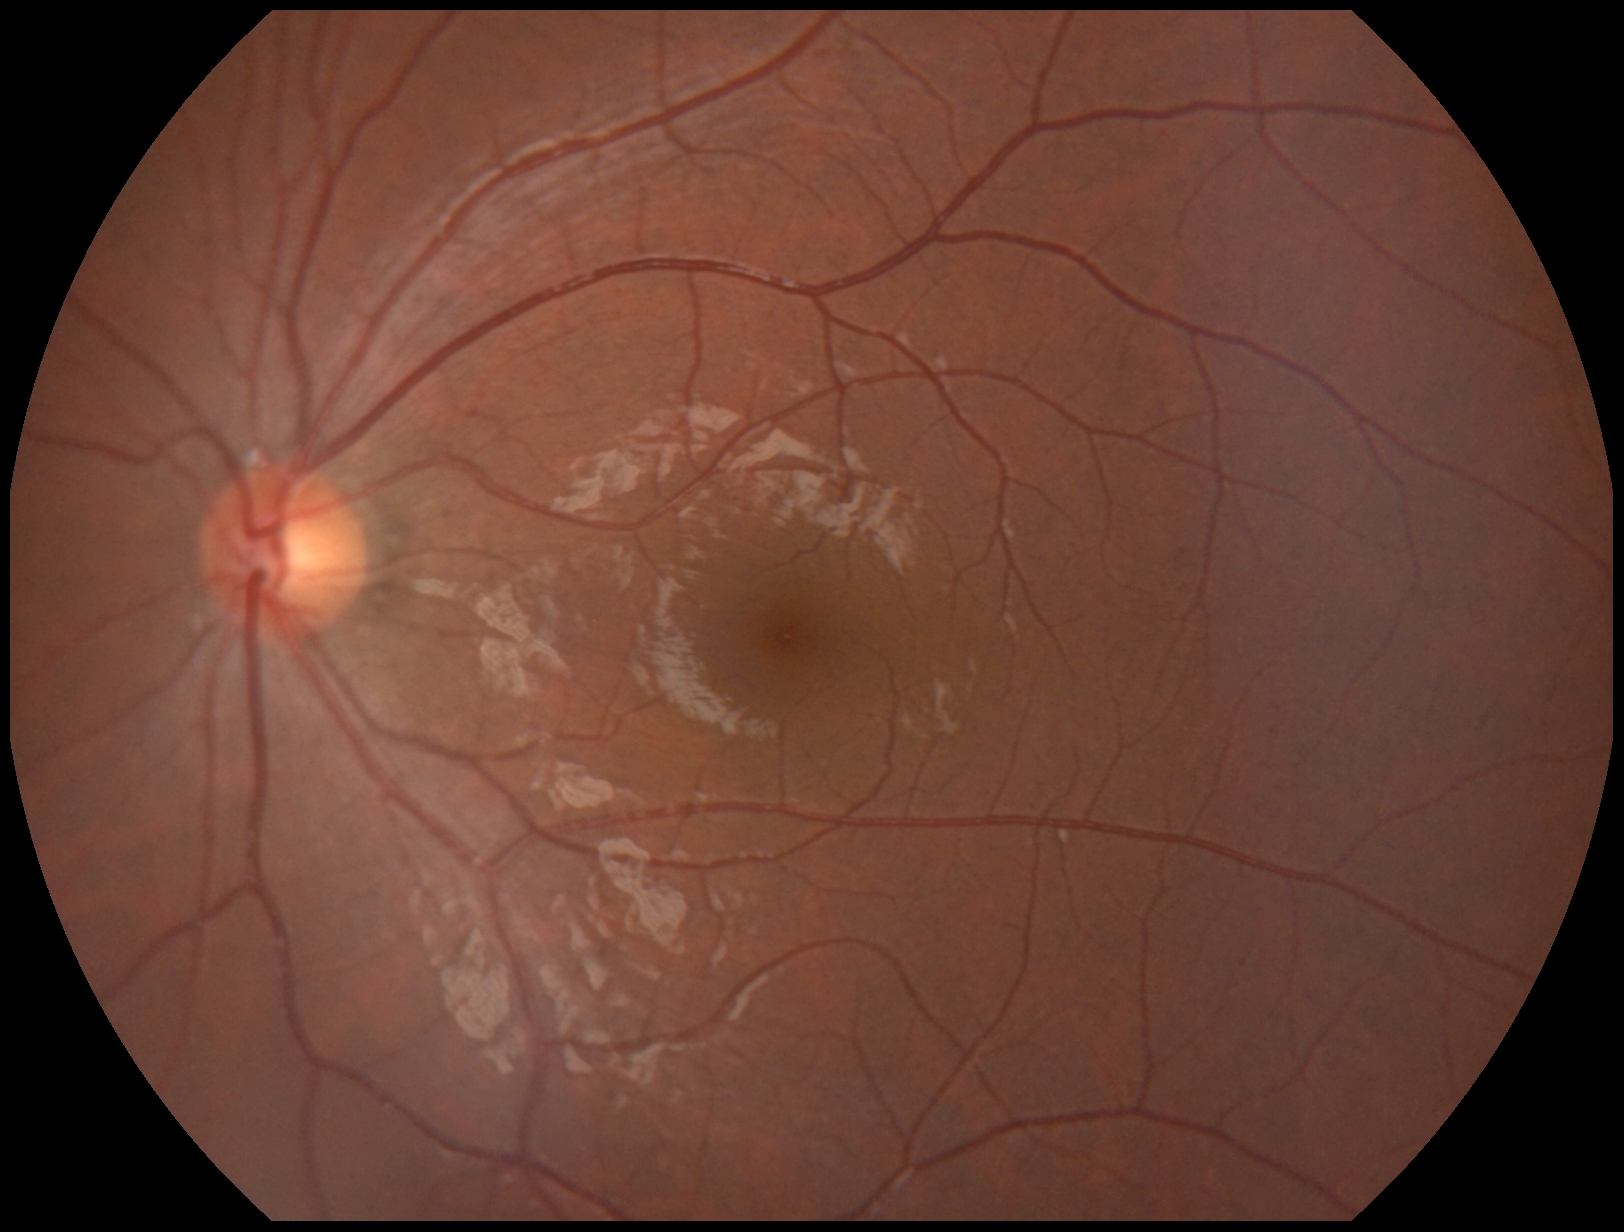 No DR findings.
DR grade: 0/4 — no visible signs of diabetic retinopathy.